Handheld portable fundus camera image: 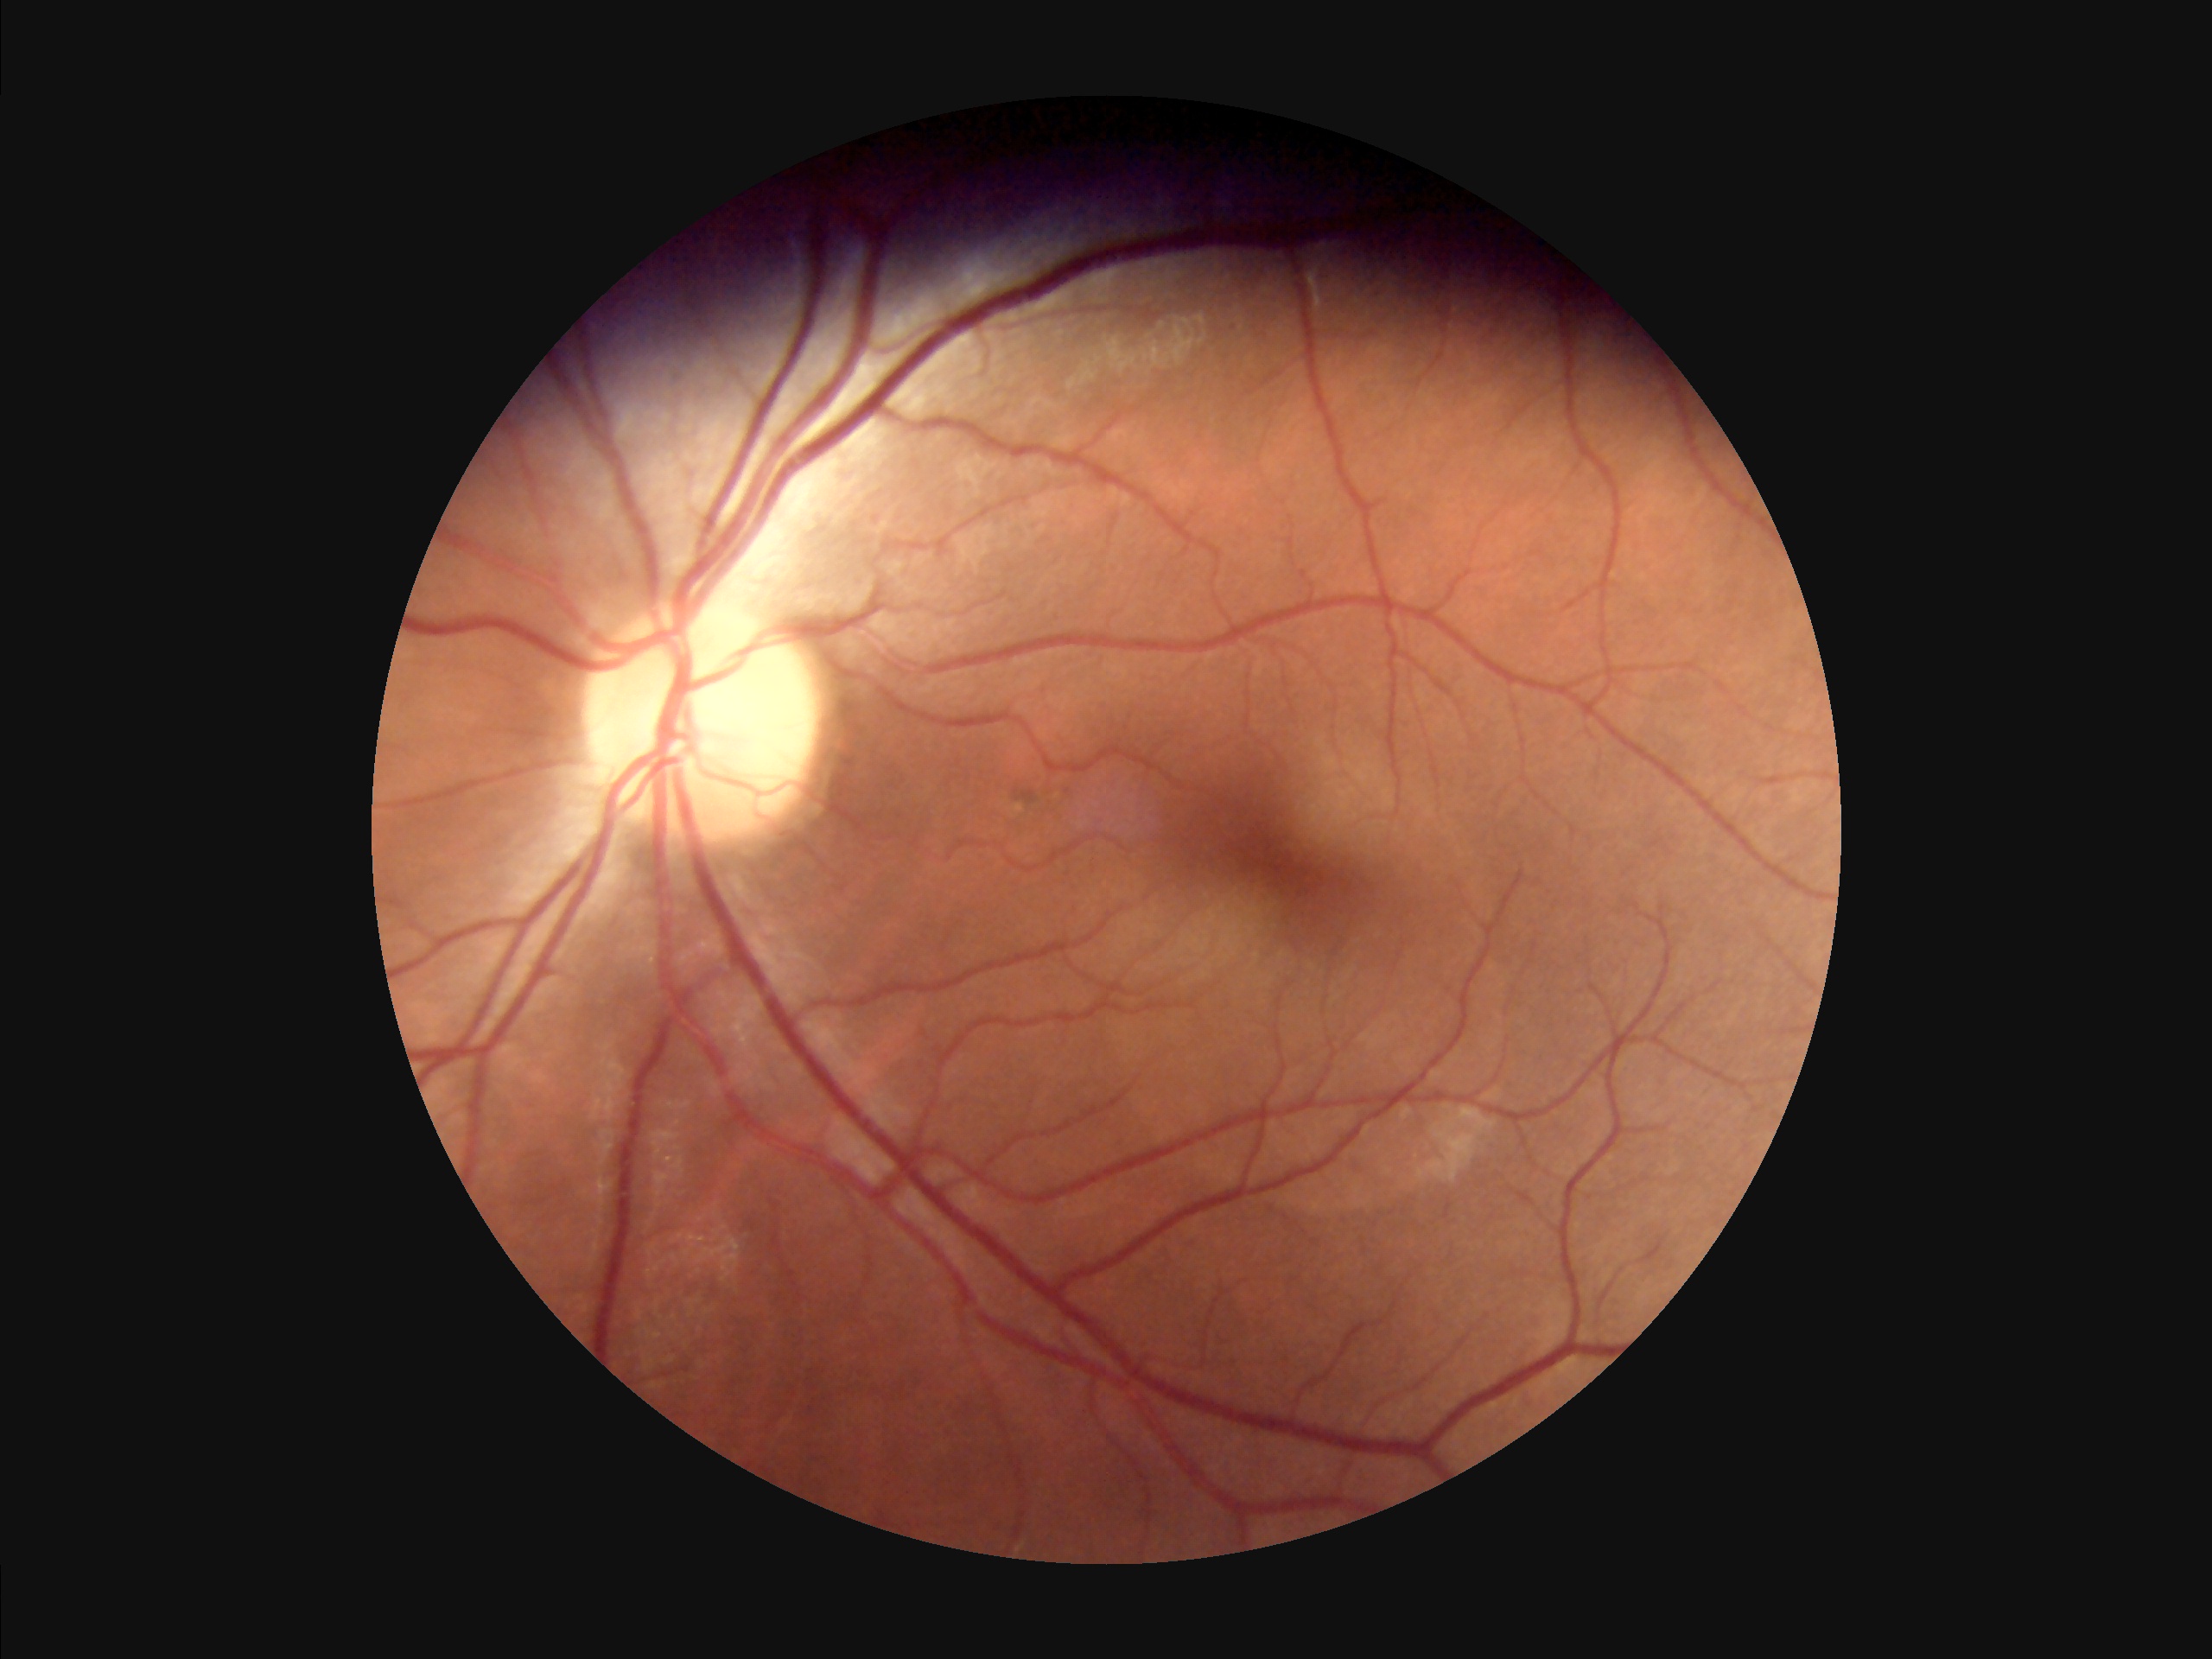
Focus: clear with no noticeable blur
Overall image quality: adequate for clinical interpretation
Illumination: uniform, no color cast